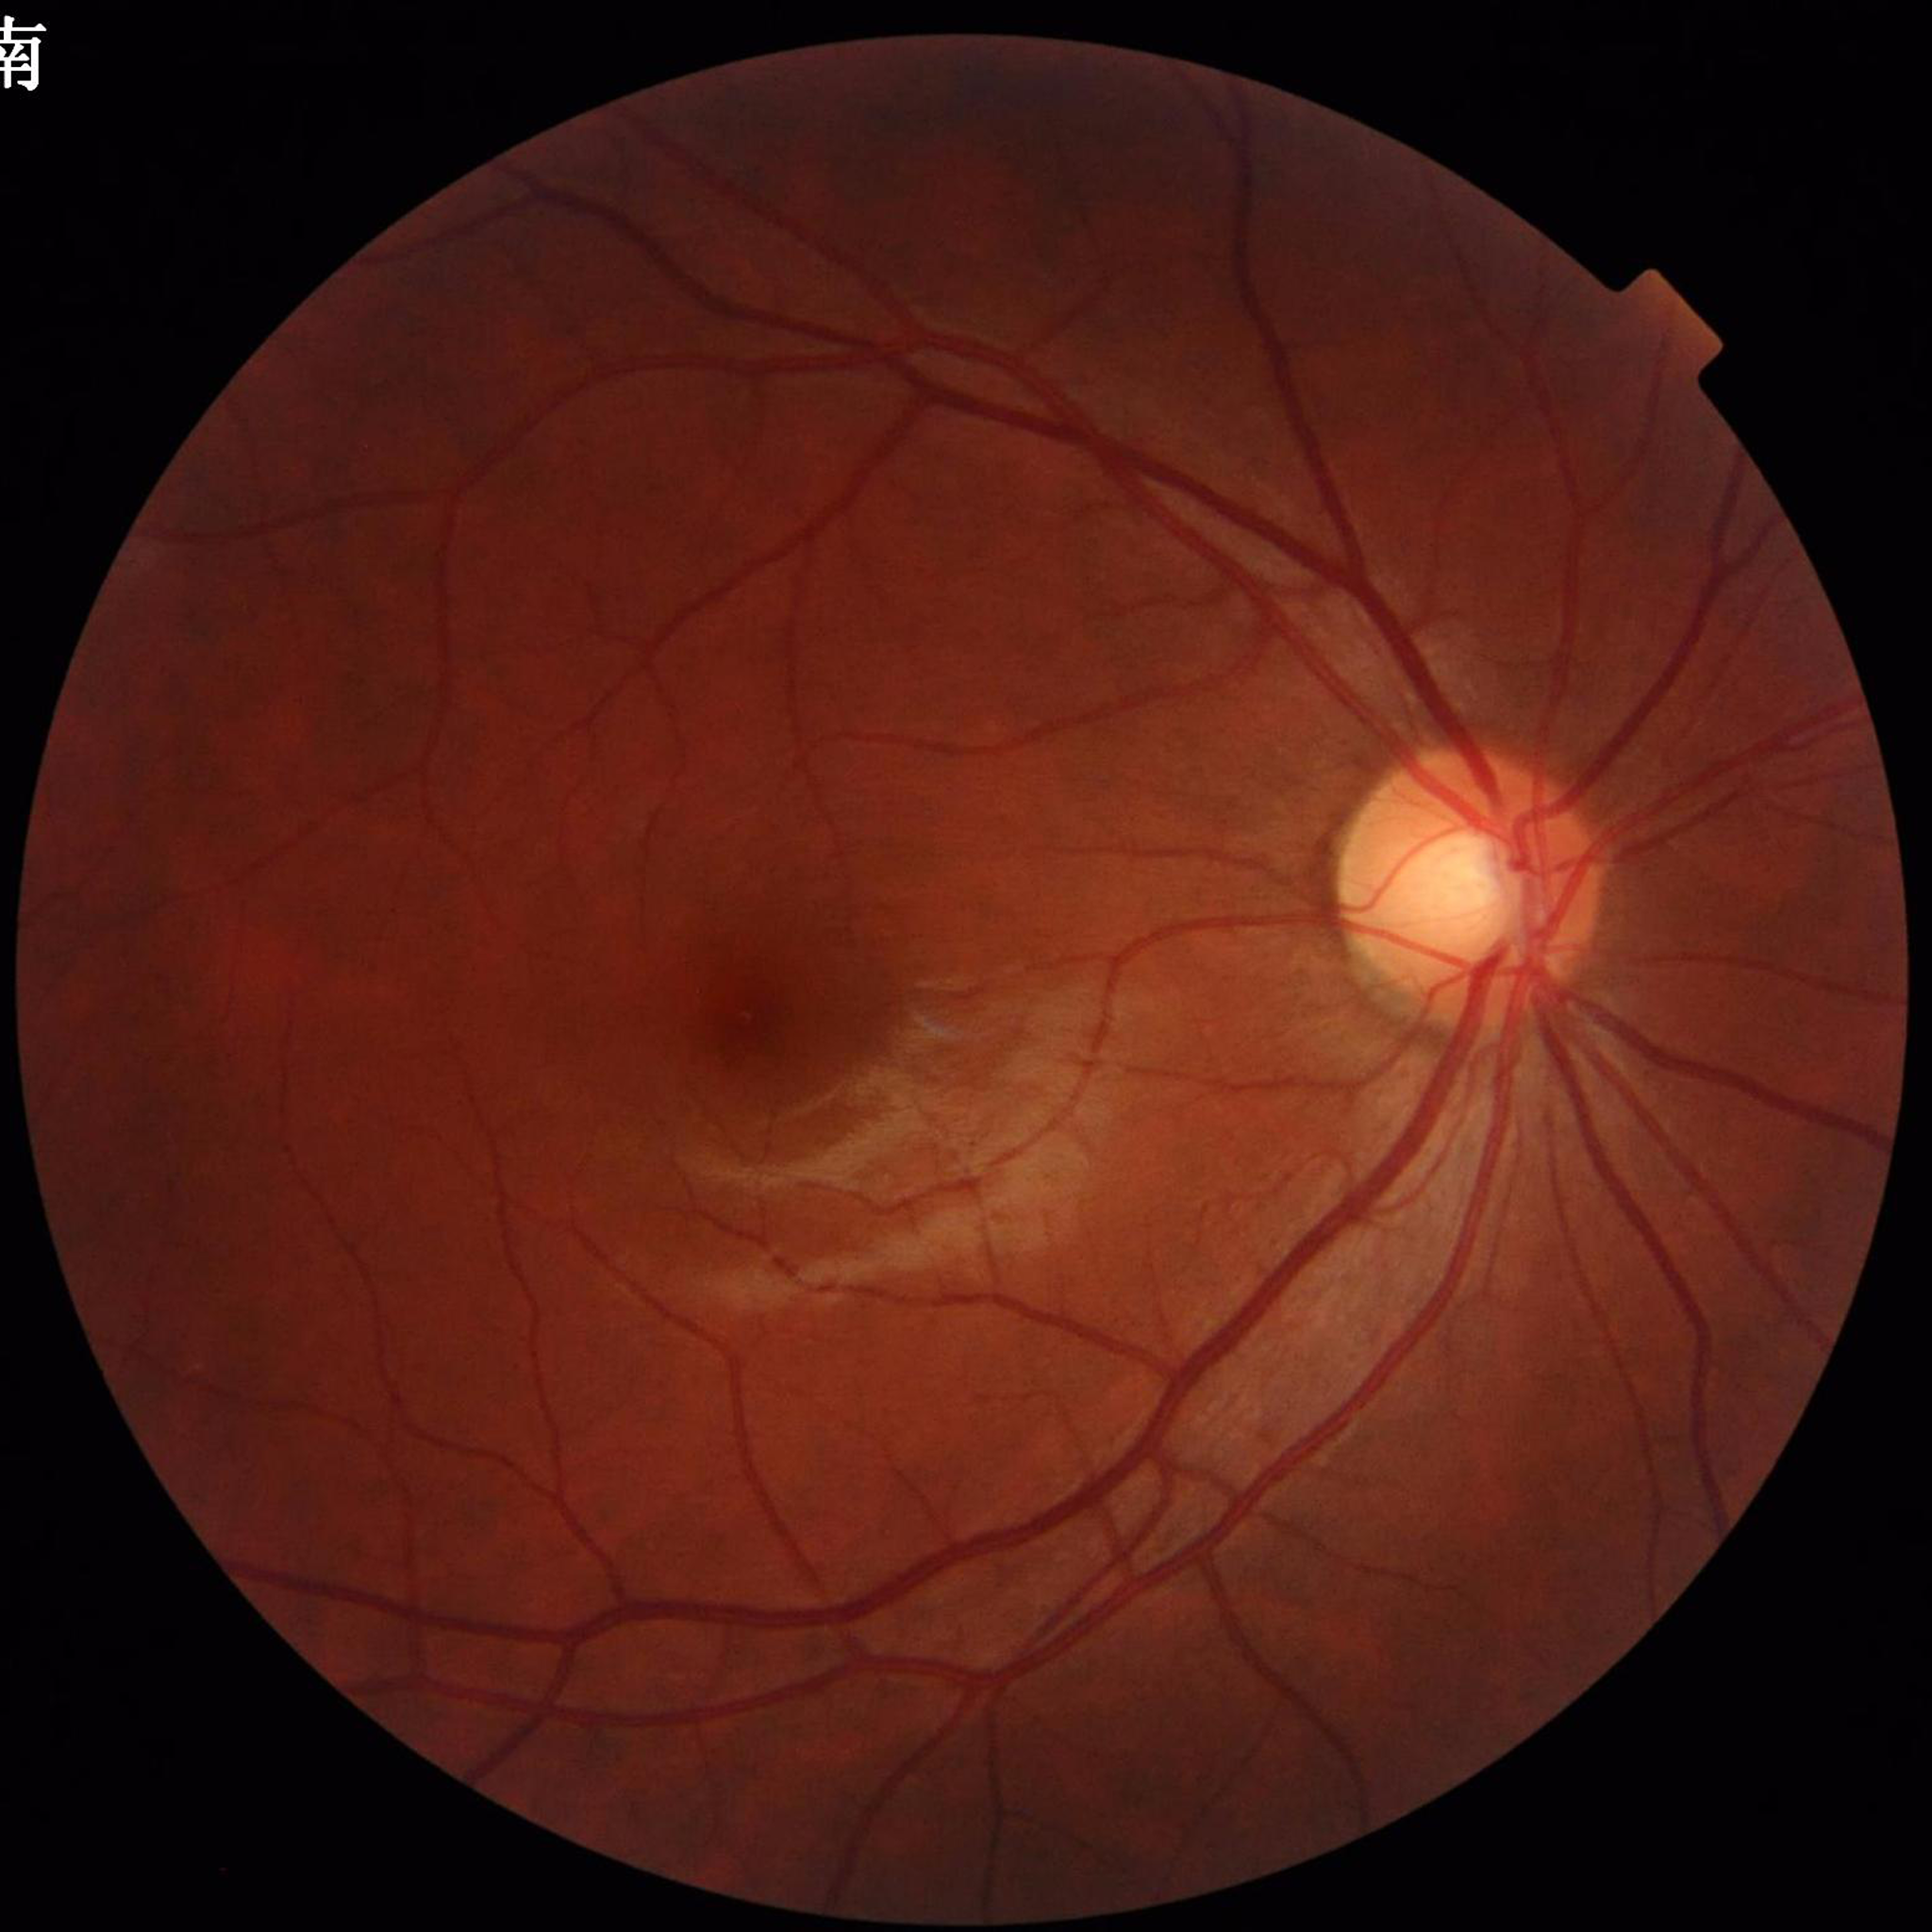
  diagnosis: glaucoma